Infant wide-field retinal image:
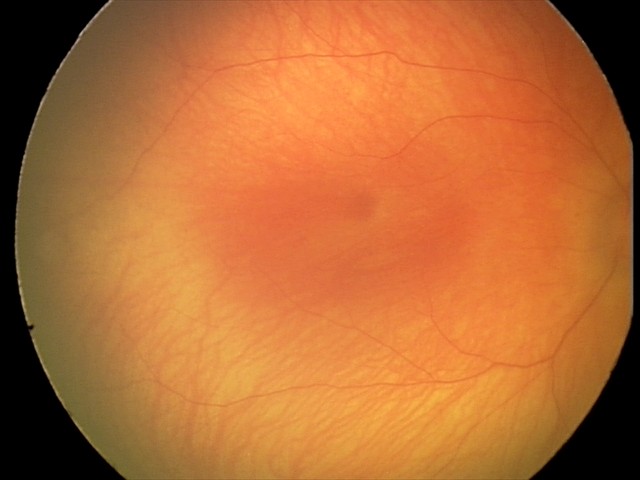

Examination with physiological retinal findings.